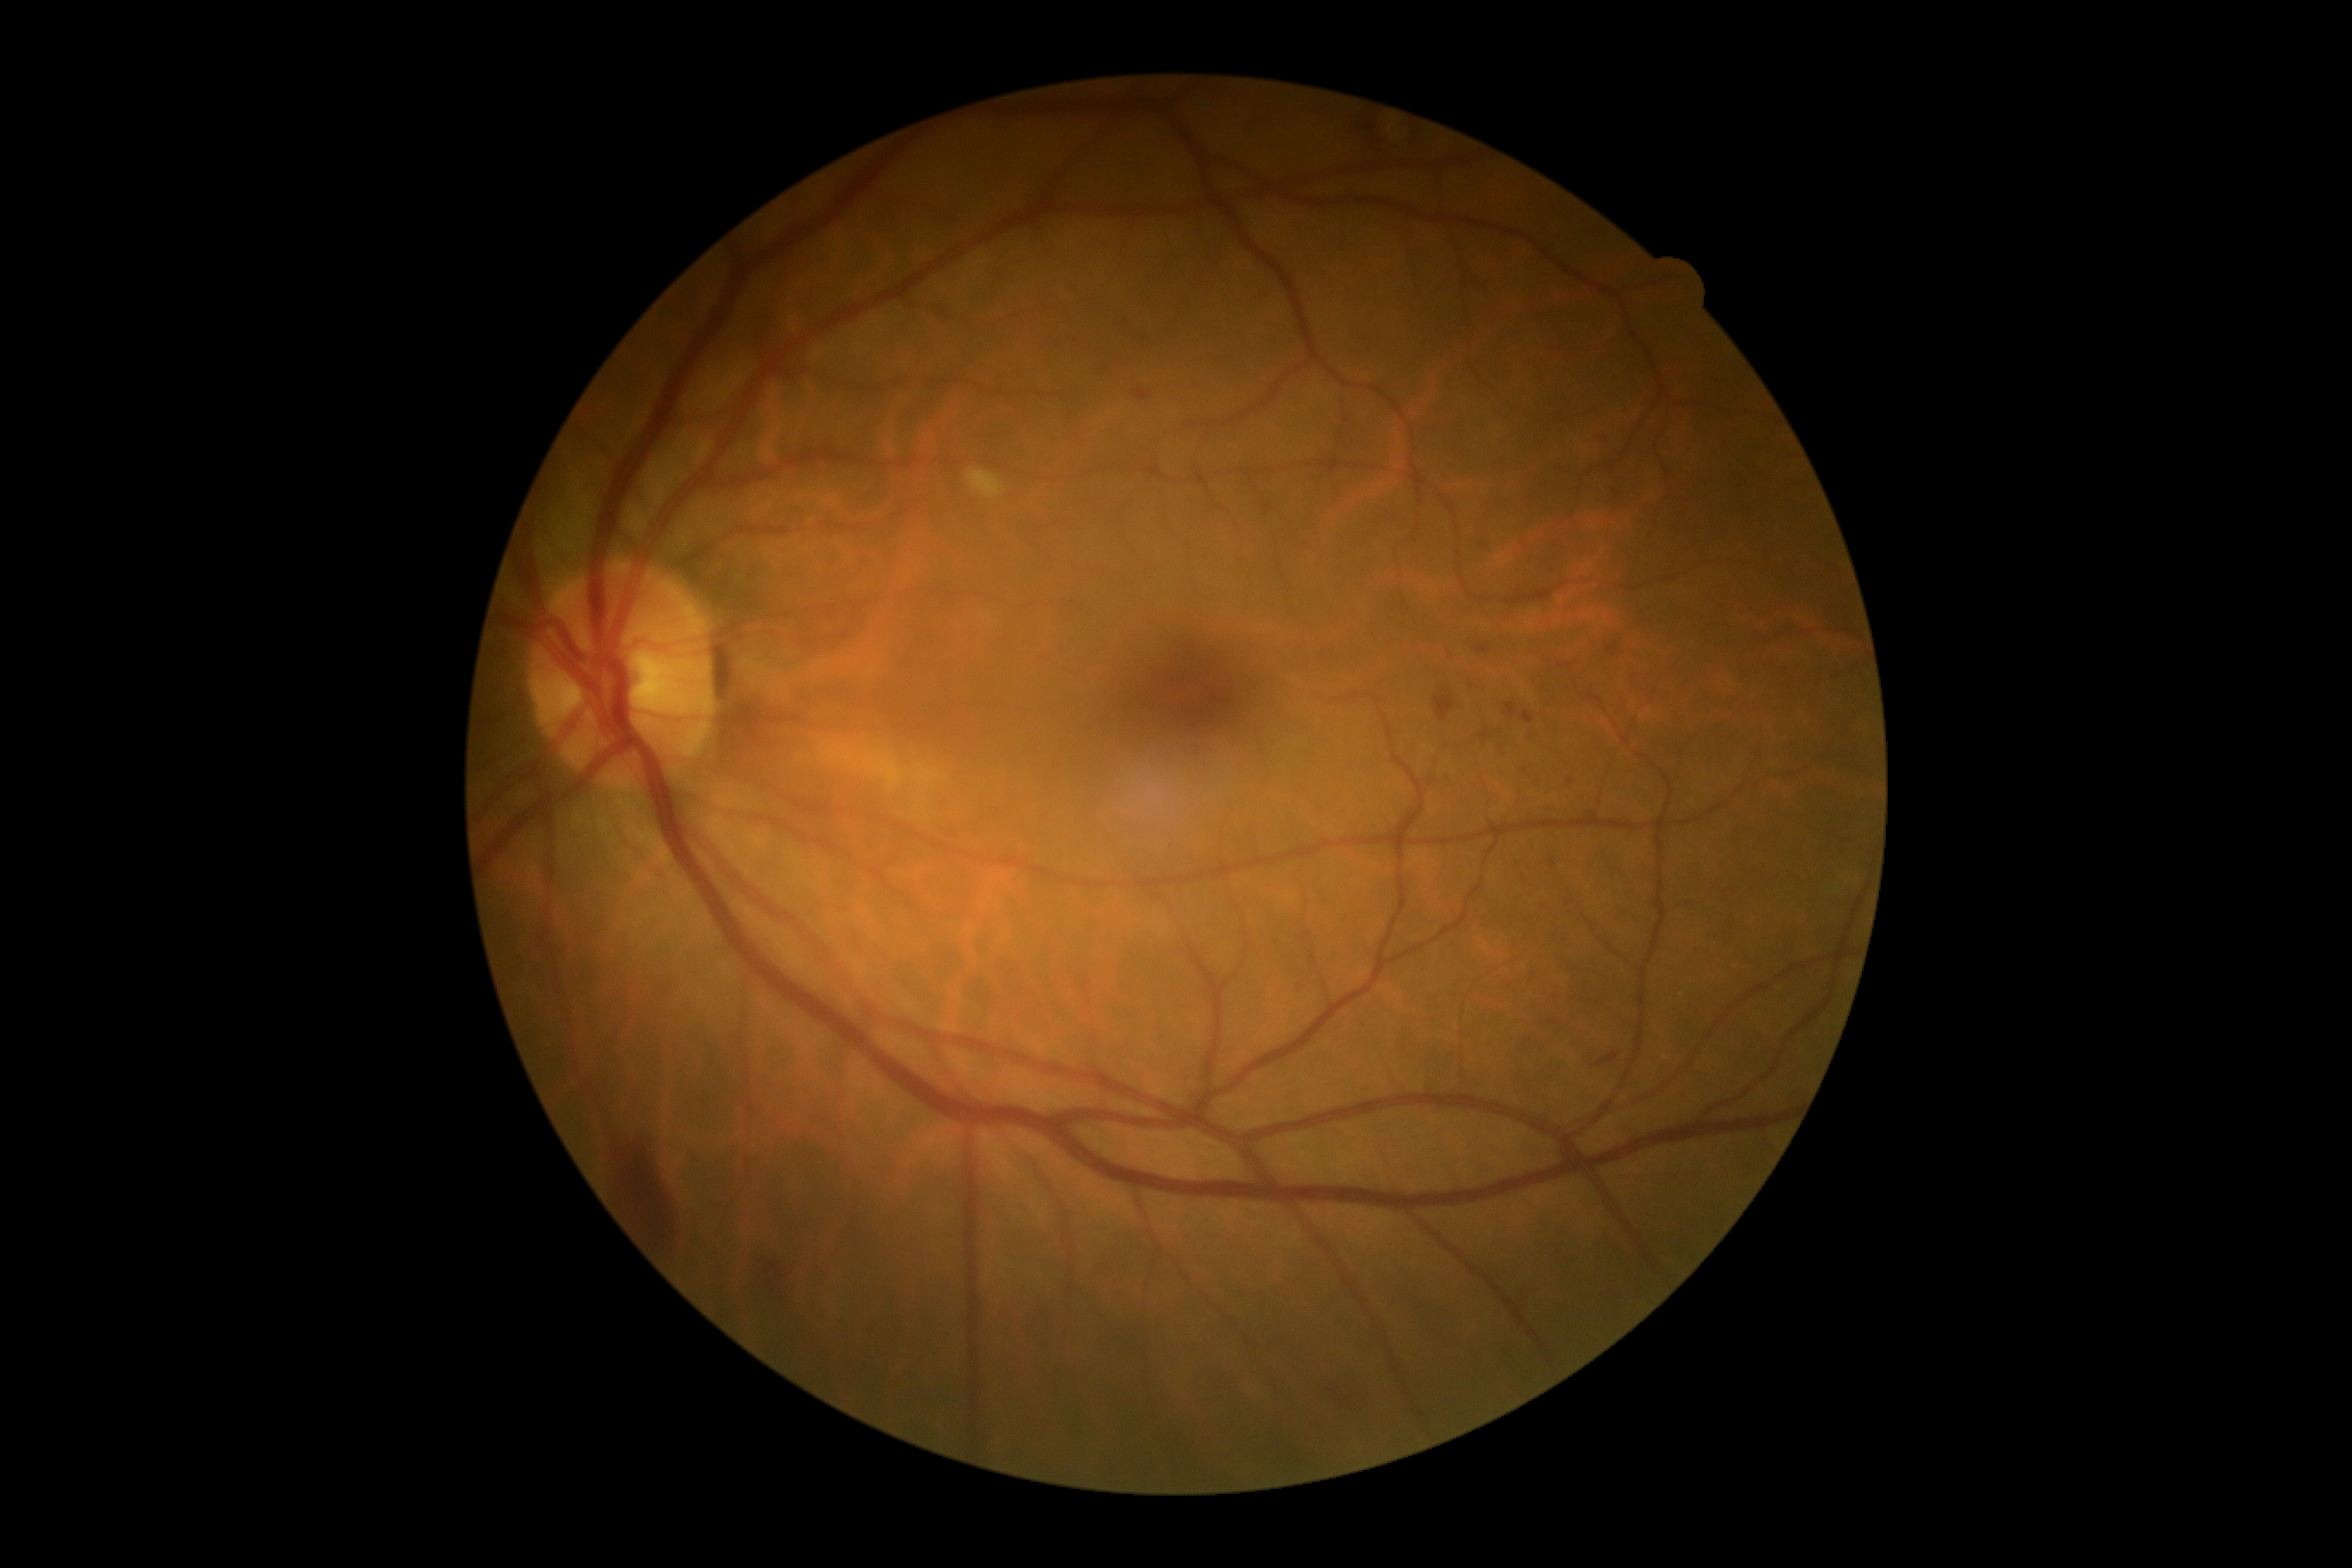 diabetic retinopathy (DR)@2/4.